CFP
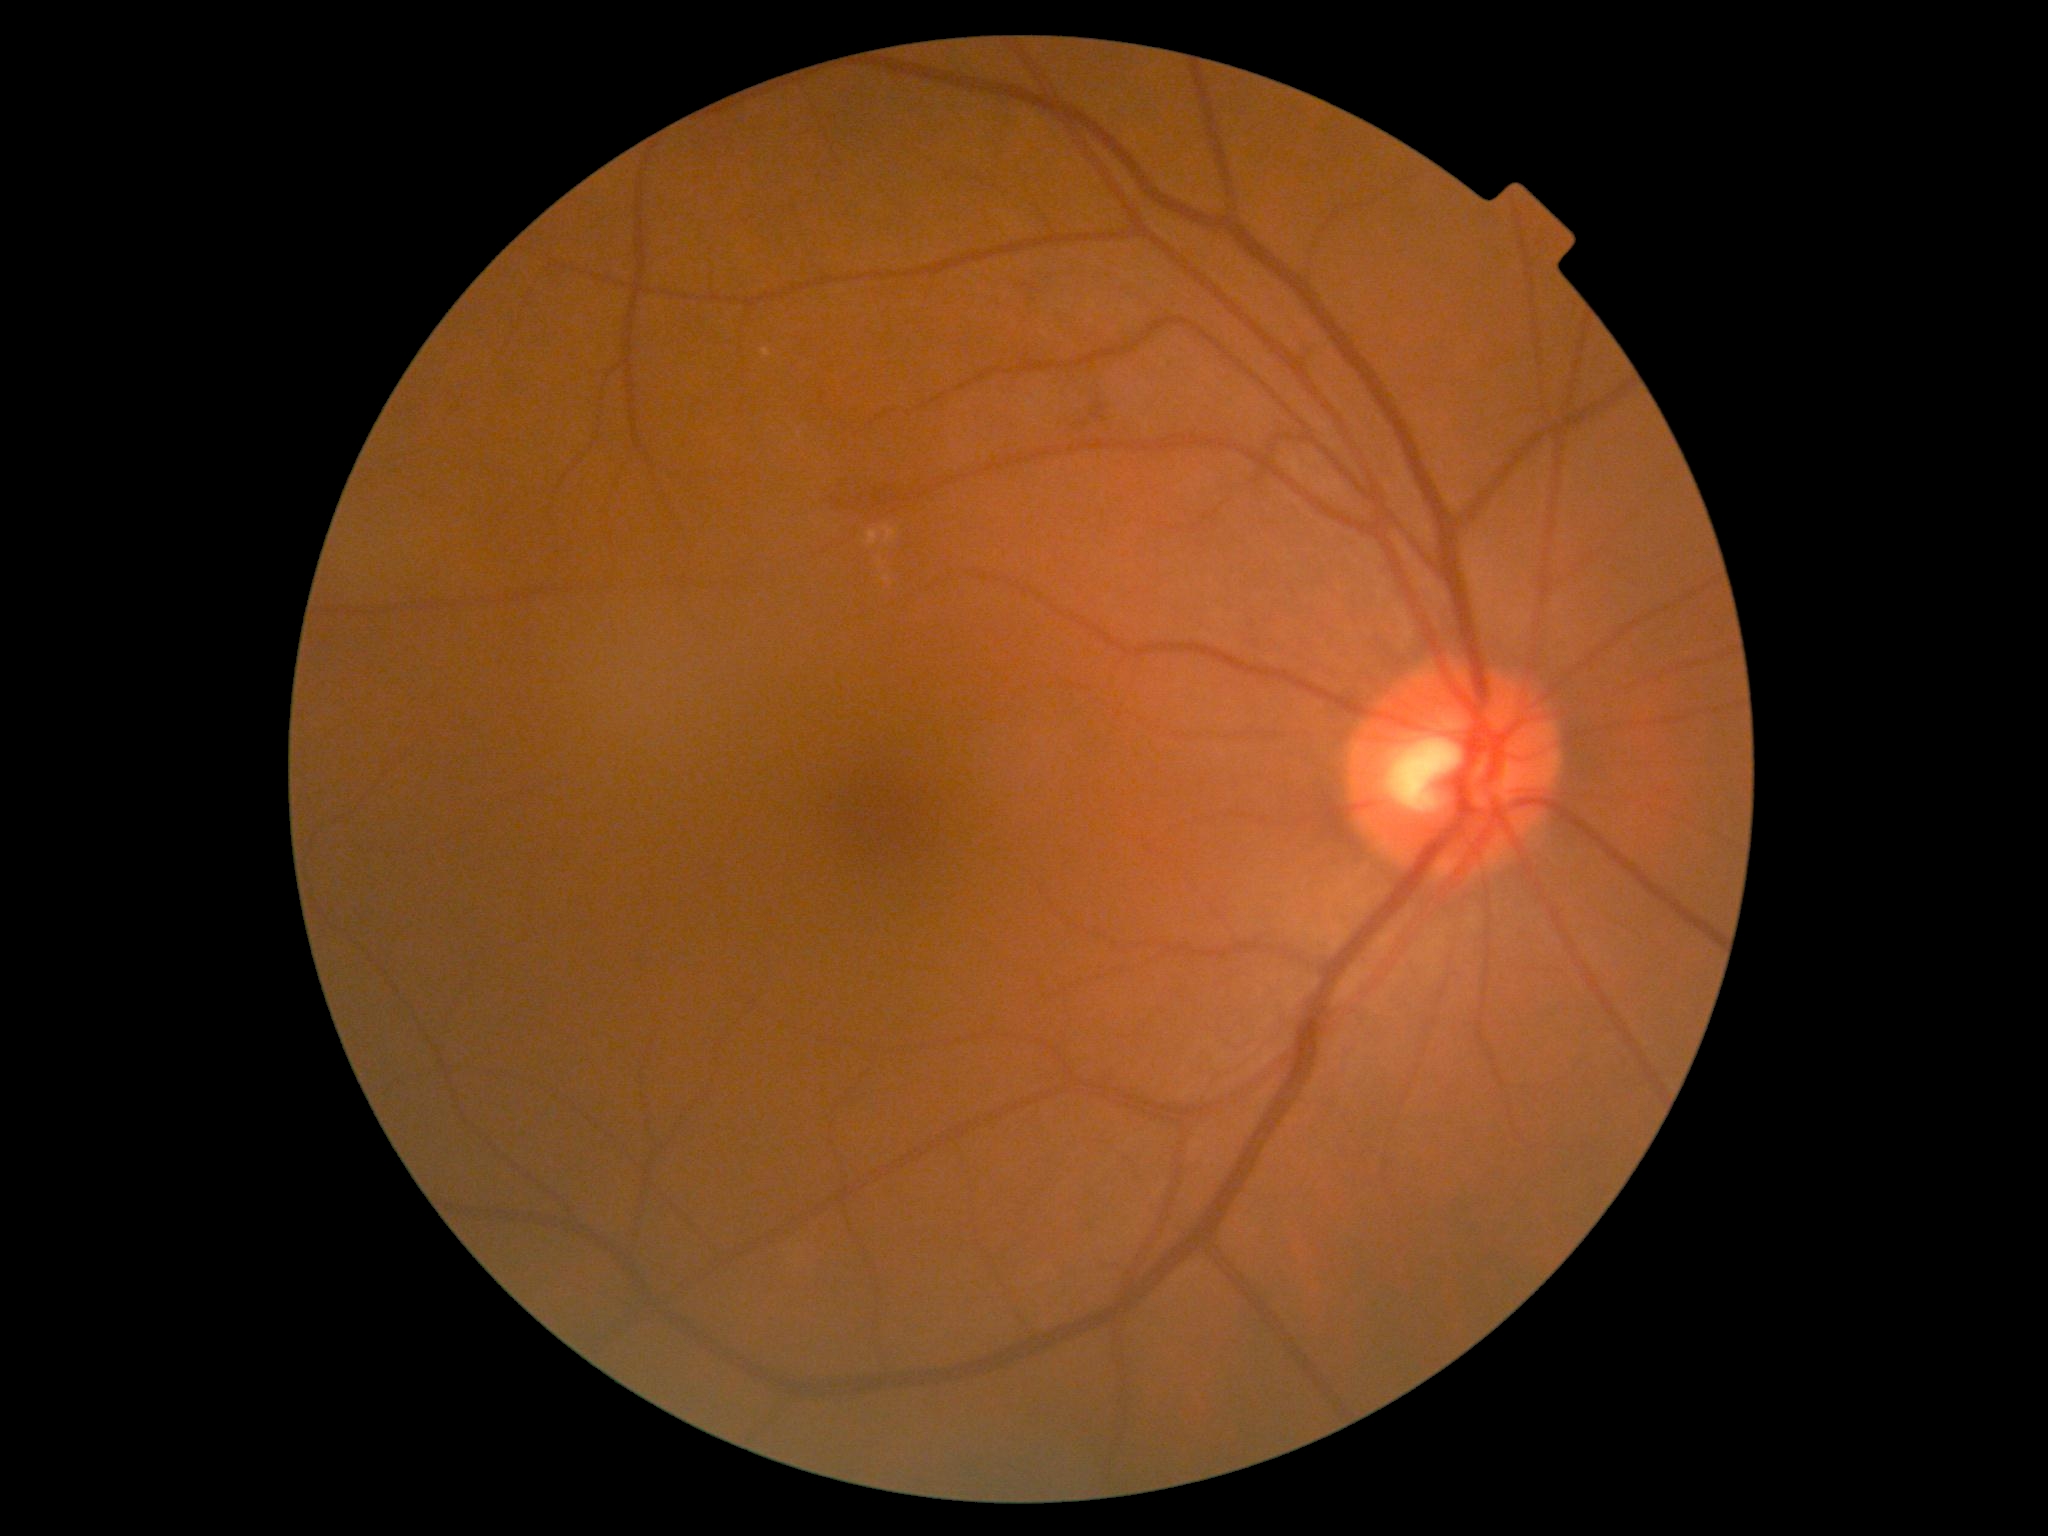
diabetic retinopathy: 2/4 | DR class: non-proliferative diabetic retinopathy.